Without pupil dilation
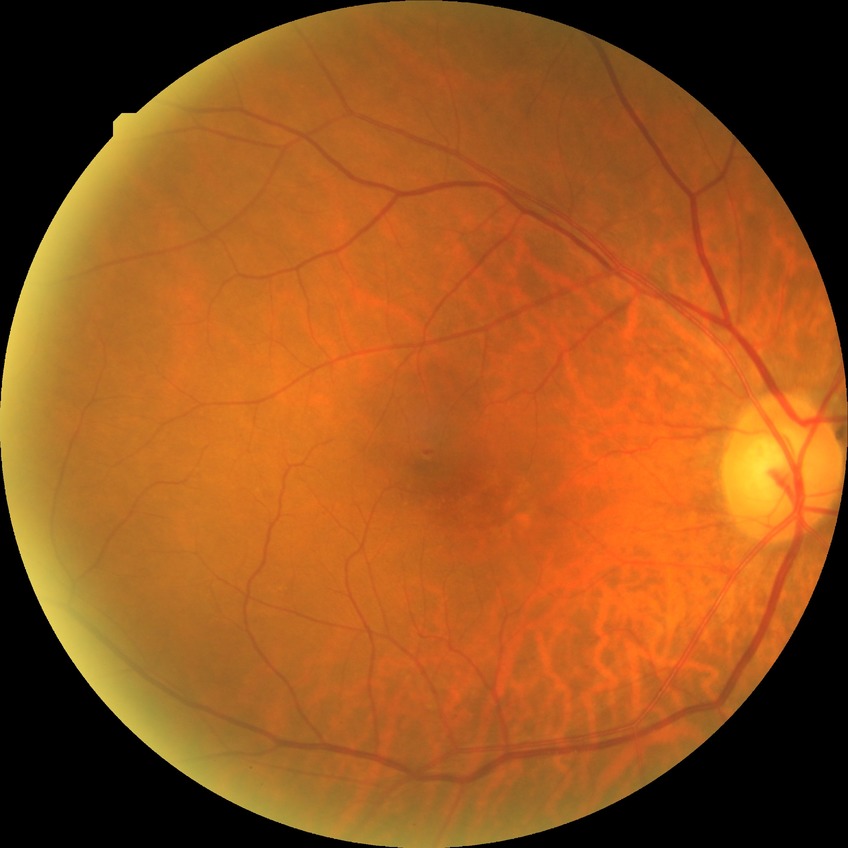

{"proliferative_class": "non-proliferative diabetic retinopathy", "davis_grade": "simple diabetic retinopathy (SDR)"}